45° FOV
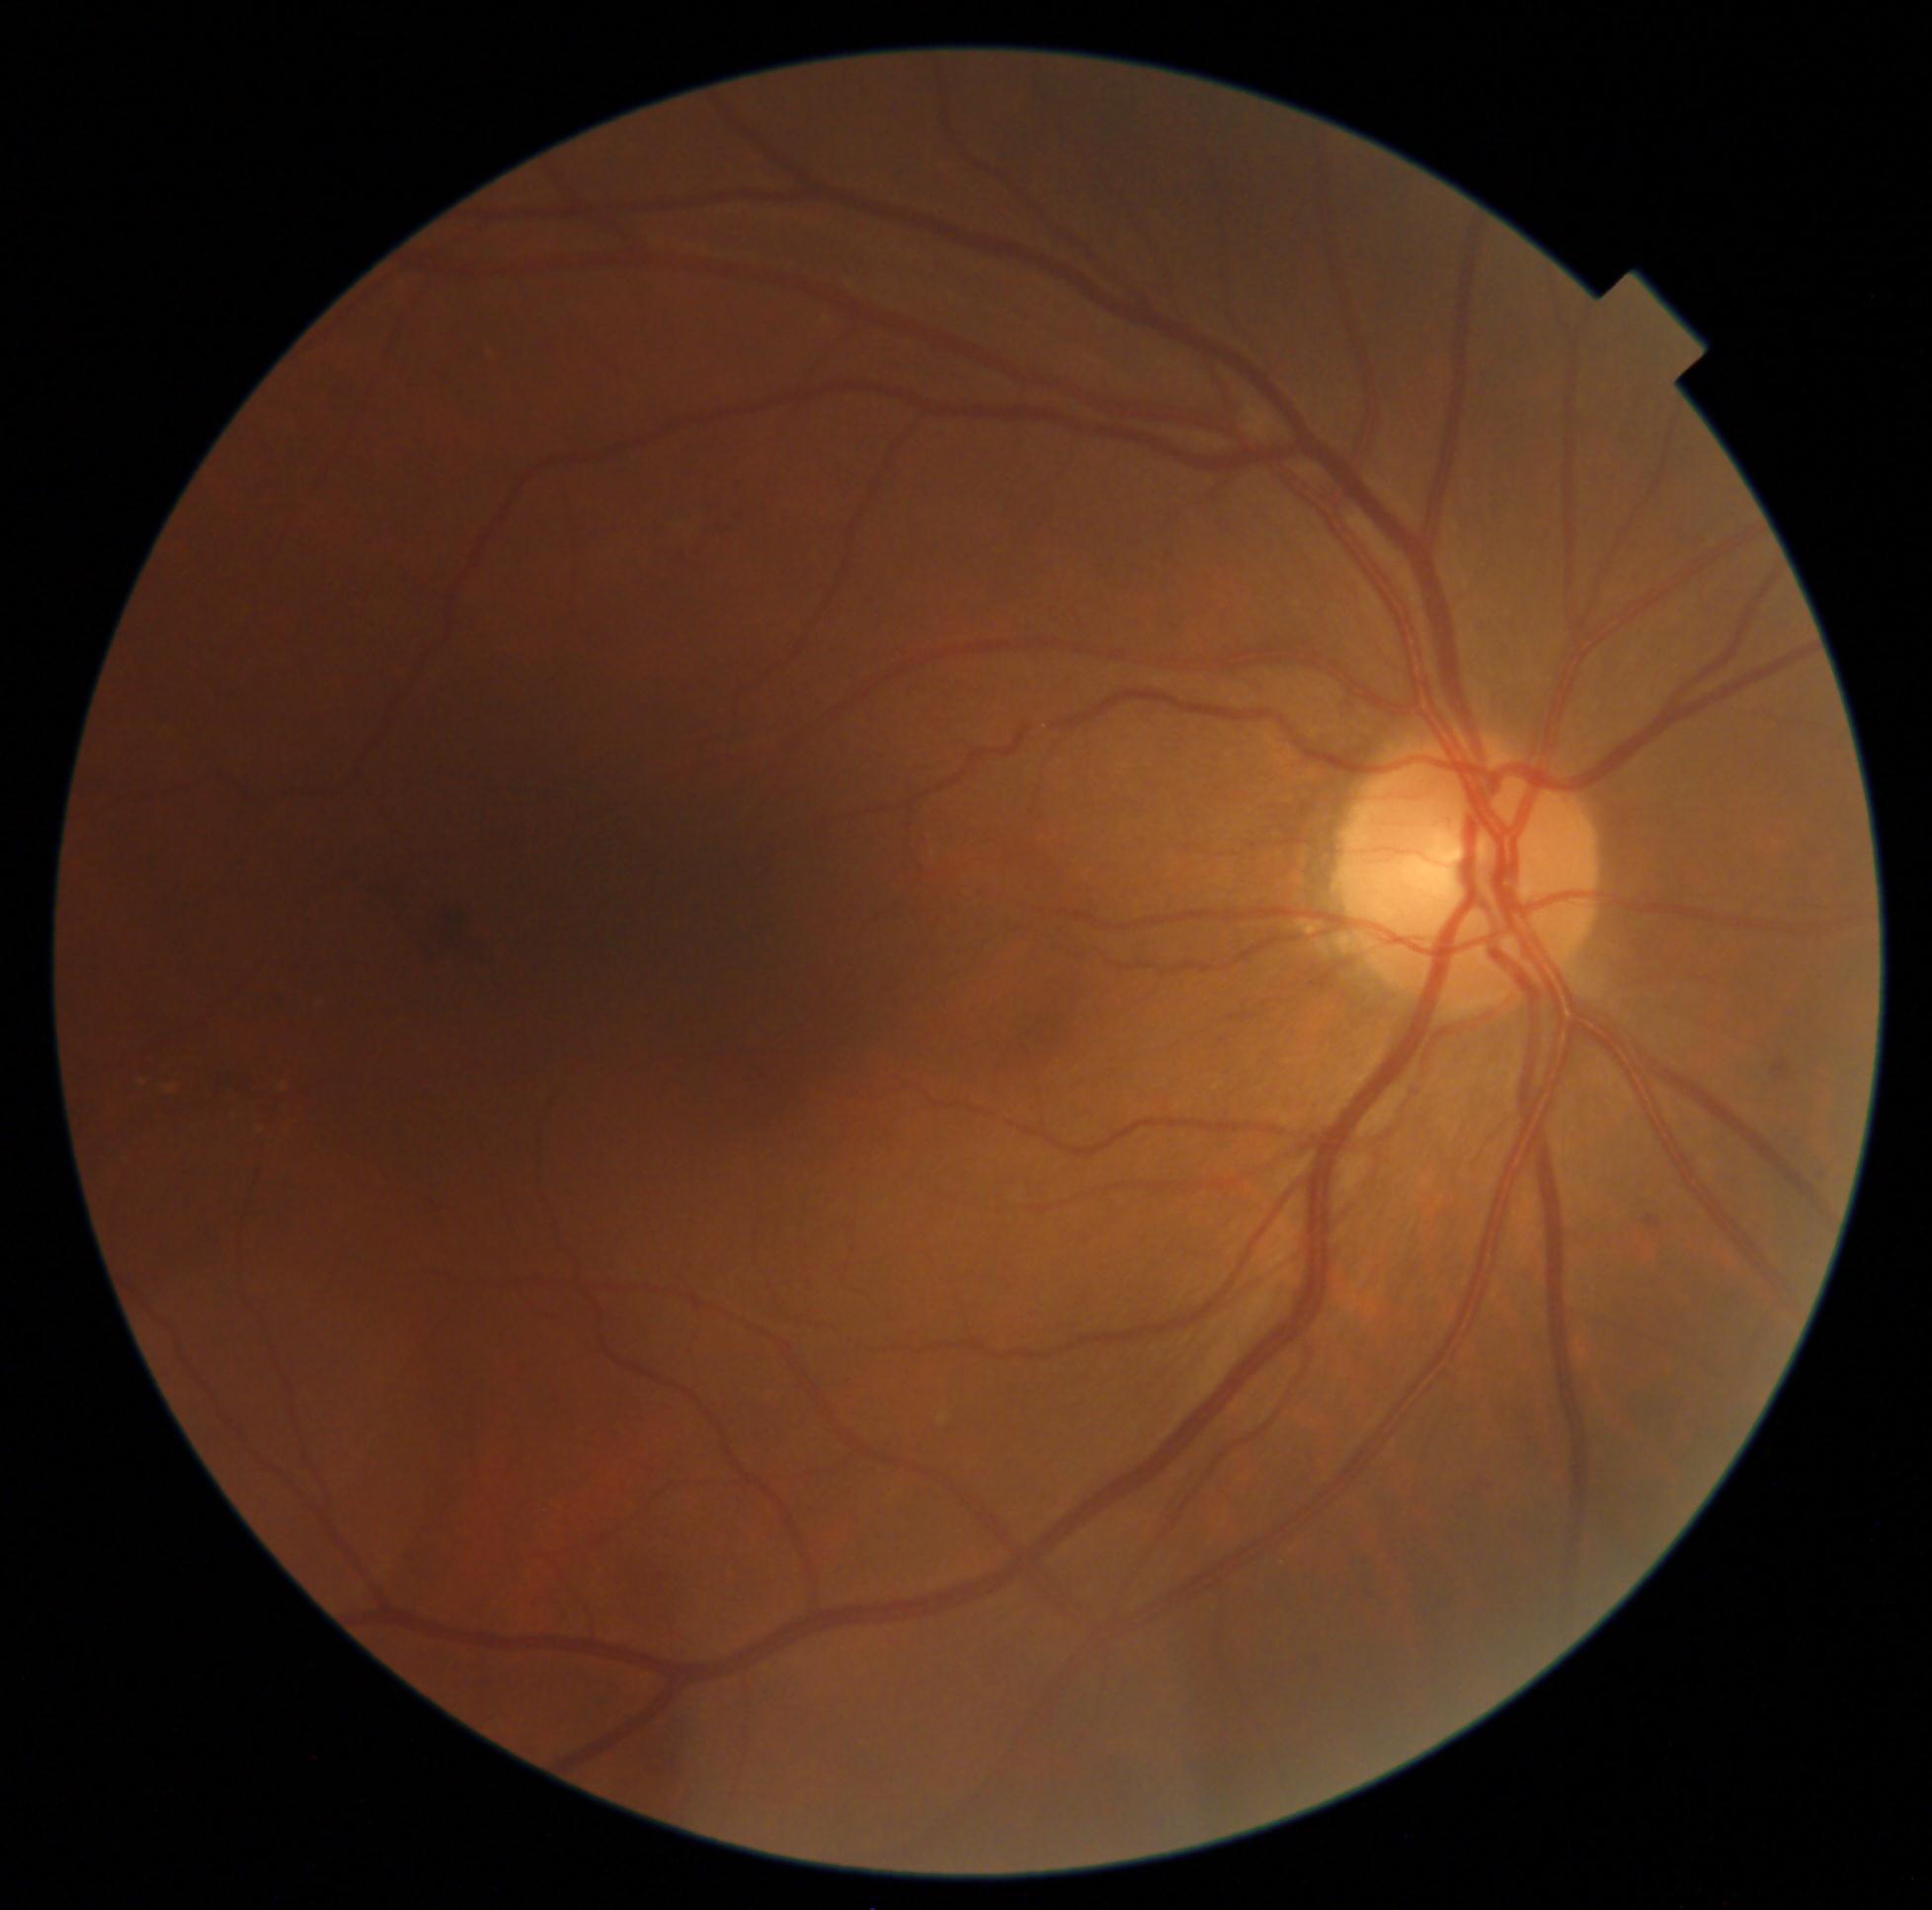
retinopathy grade = 2